848x848px · acquired with a NIDEK AFC-230 · color fundus photograph: 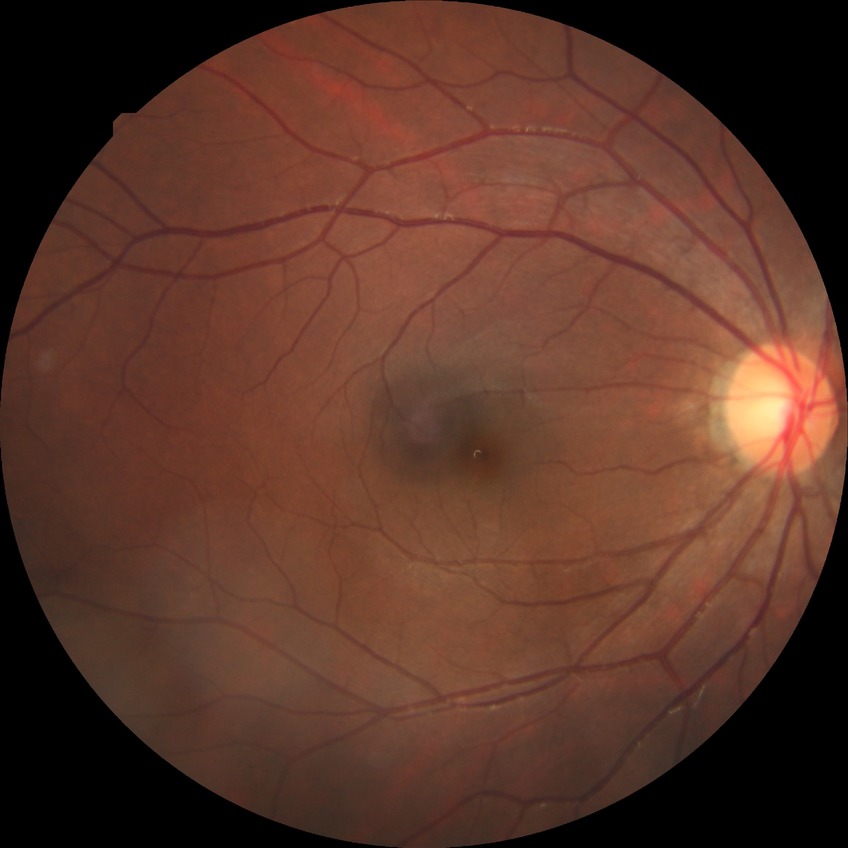

No DR findings.
Davis stage is NDR.